Davis DR grading: 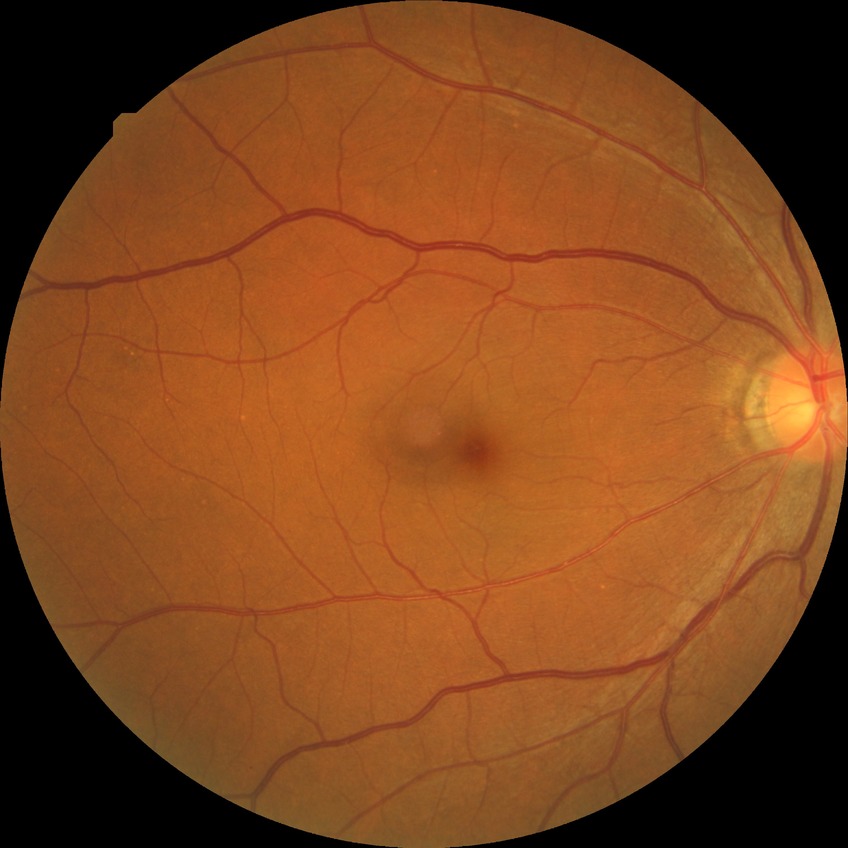
Diabetic retinopathy (DR): no diabetic retinopathy (NDR).